FOV: 45 degrees · CFP
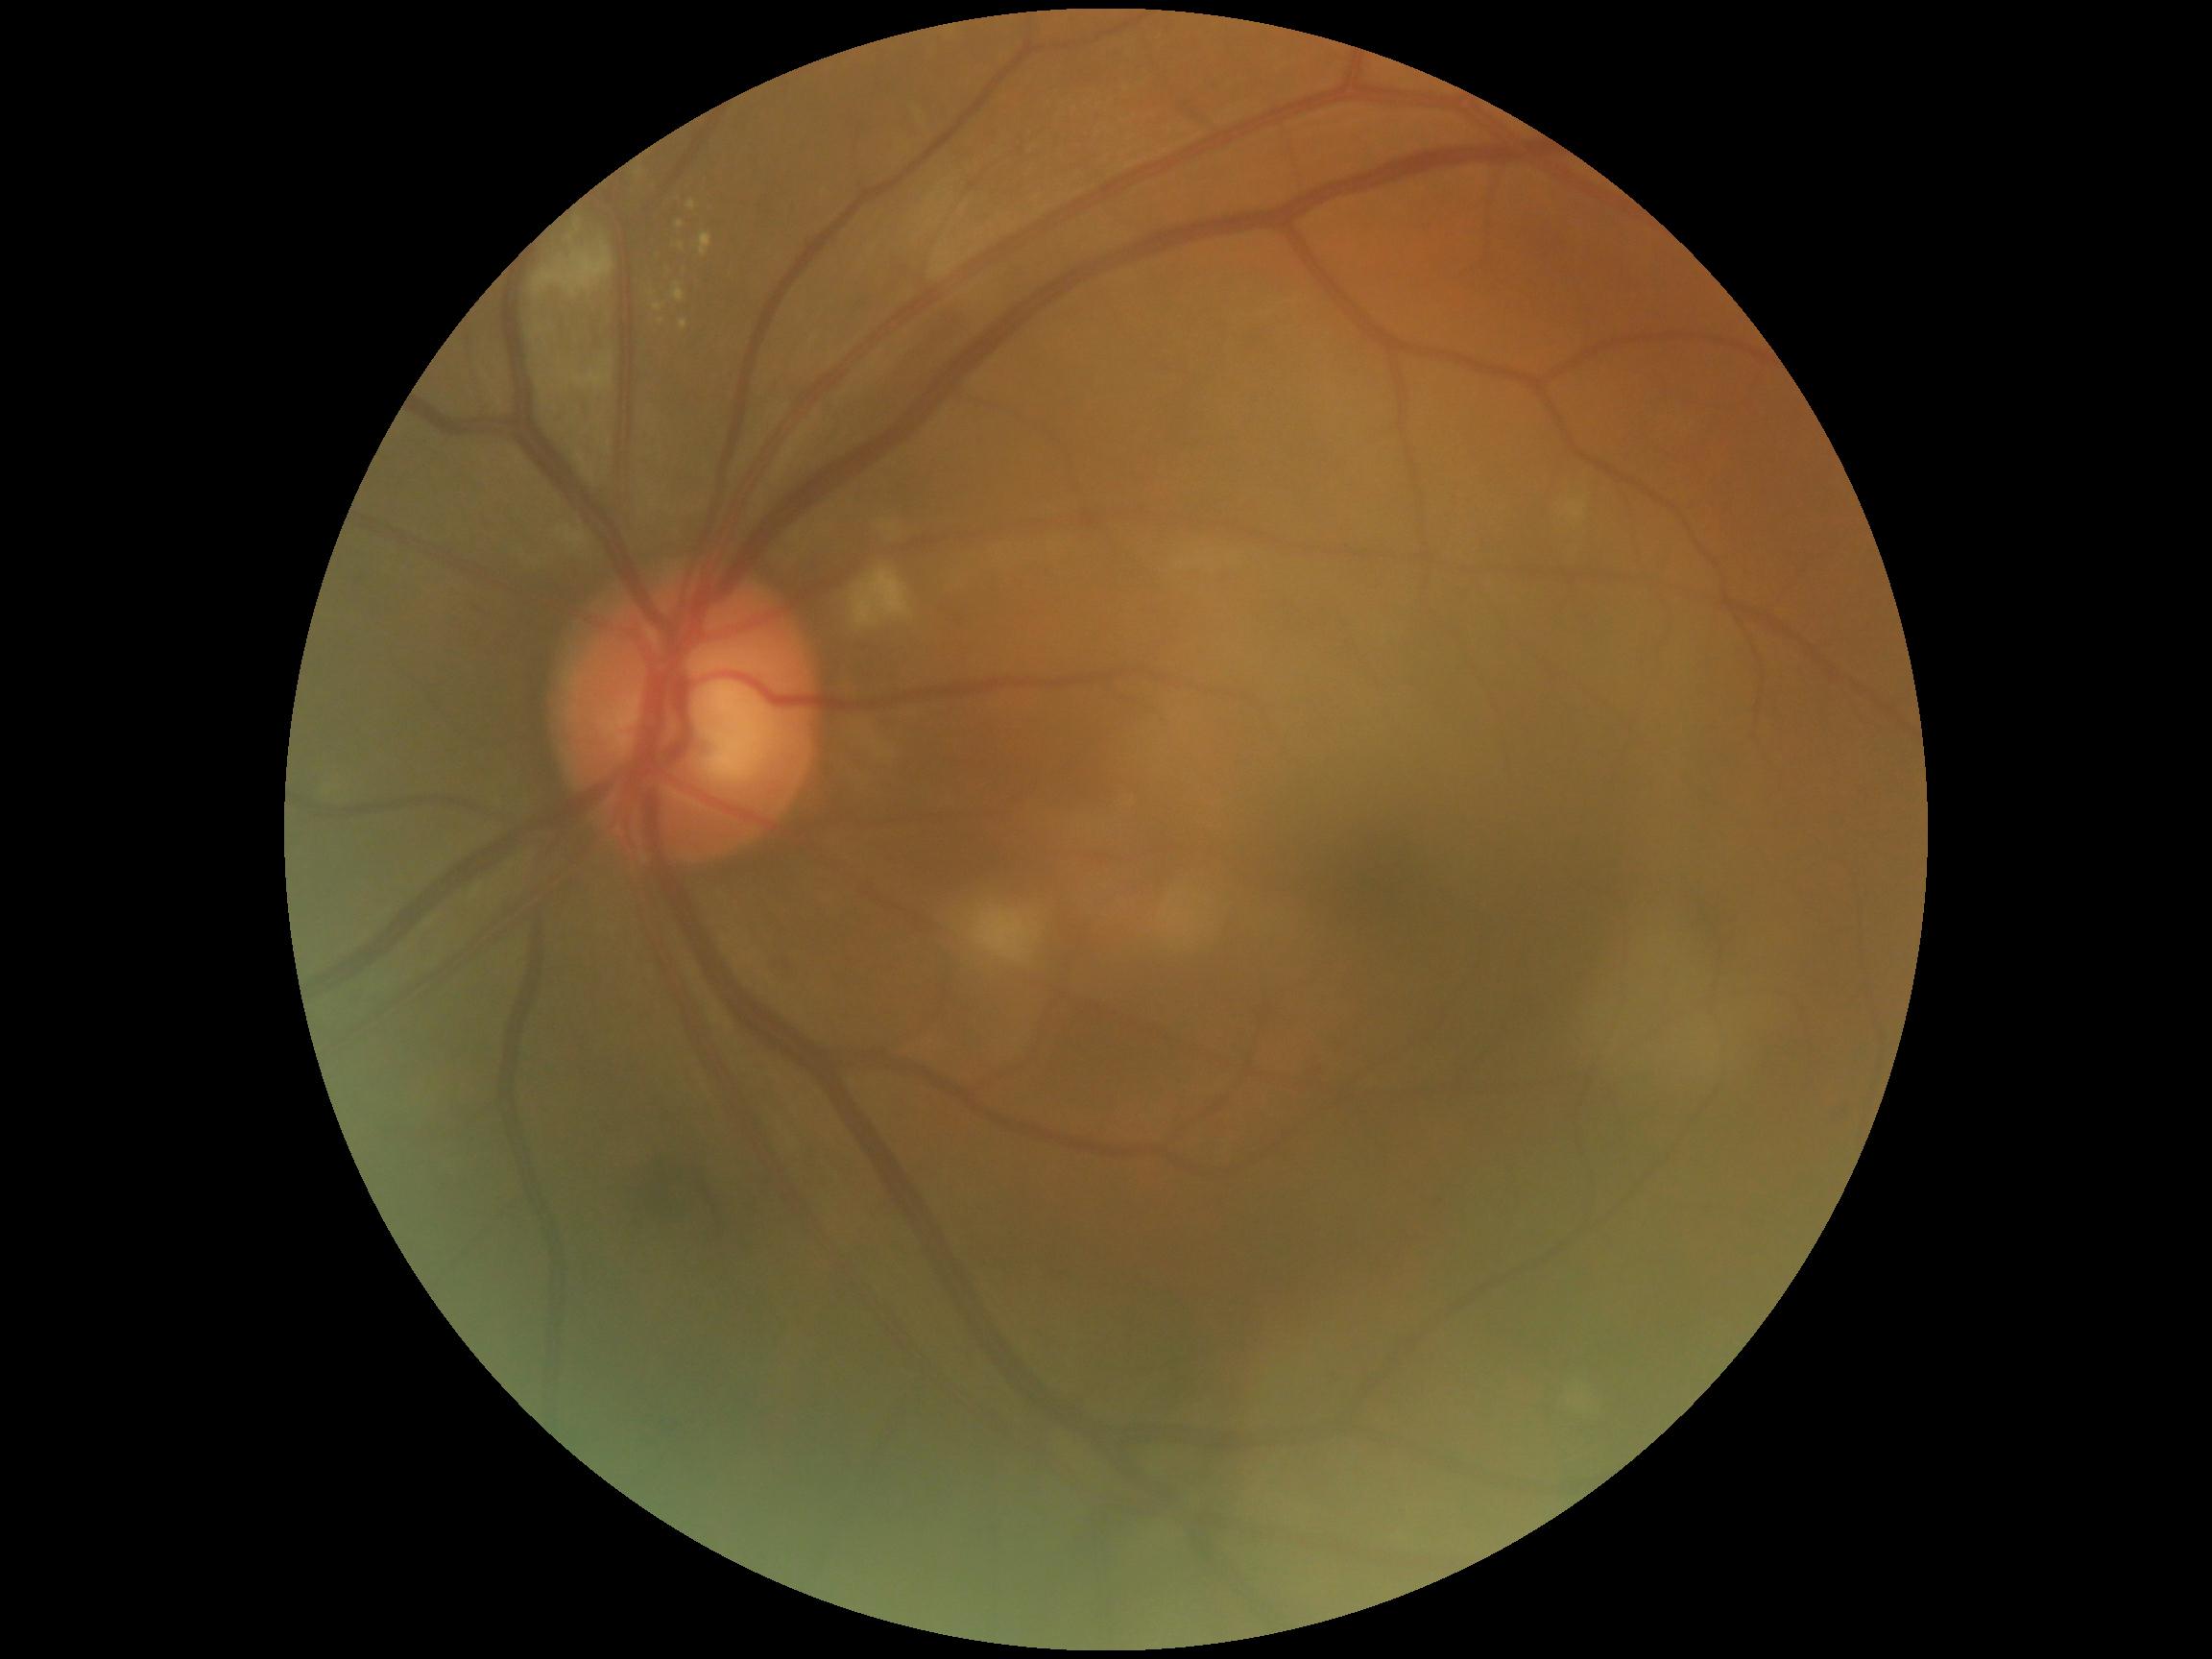

Diabetic retinopathy (DR) is 2/4.